ONH-centered crop from a color fundus image · FOV 35° before cropping:
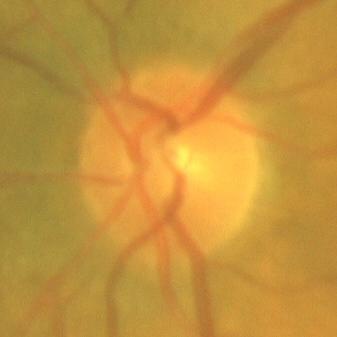
Consistent with no glaucomatous findings.